Color fundus photograph.
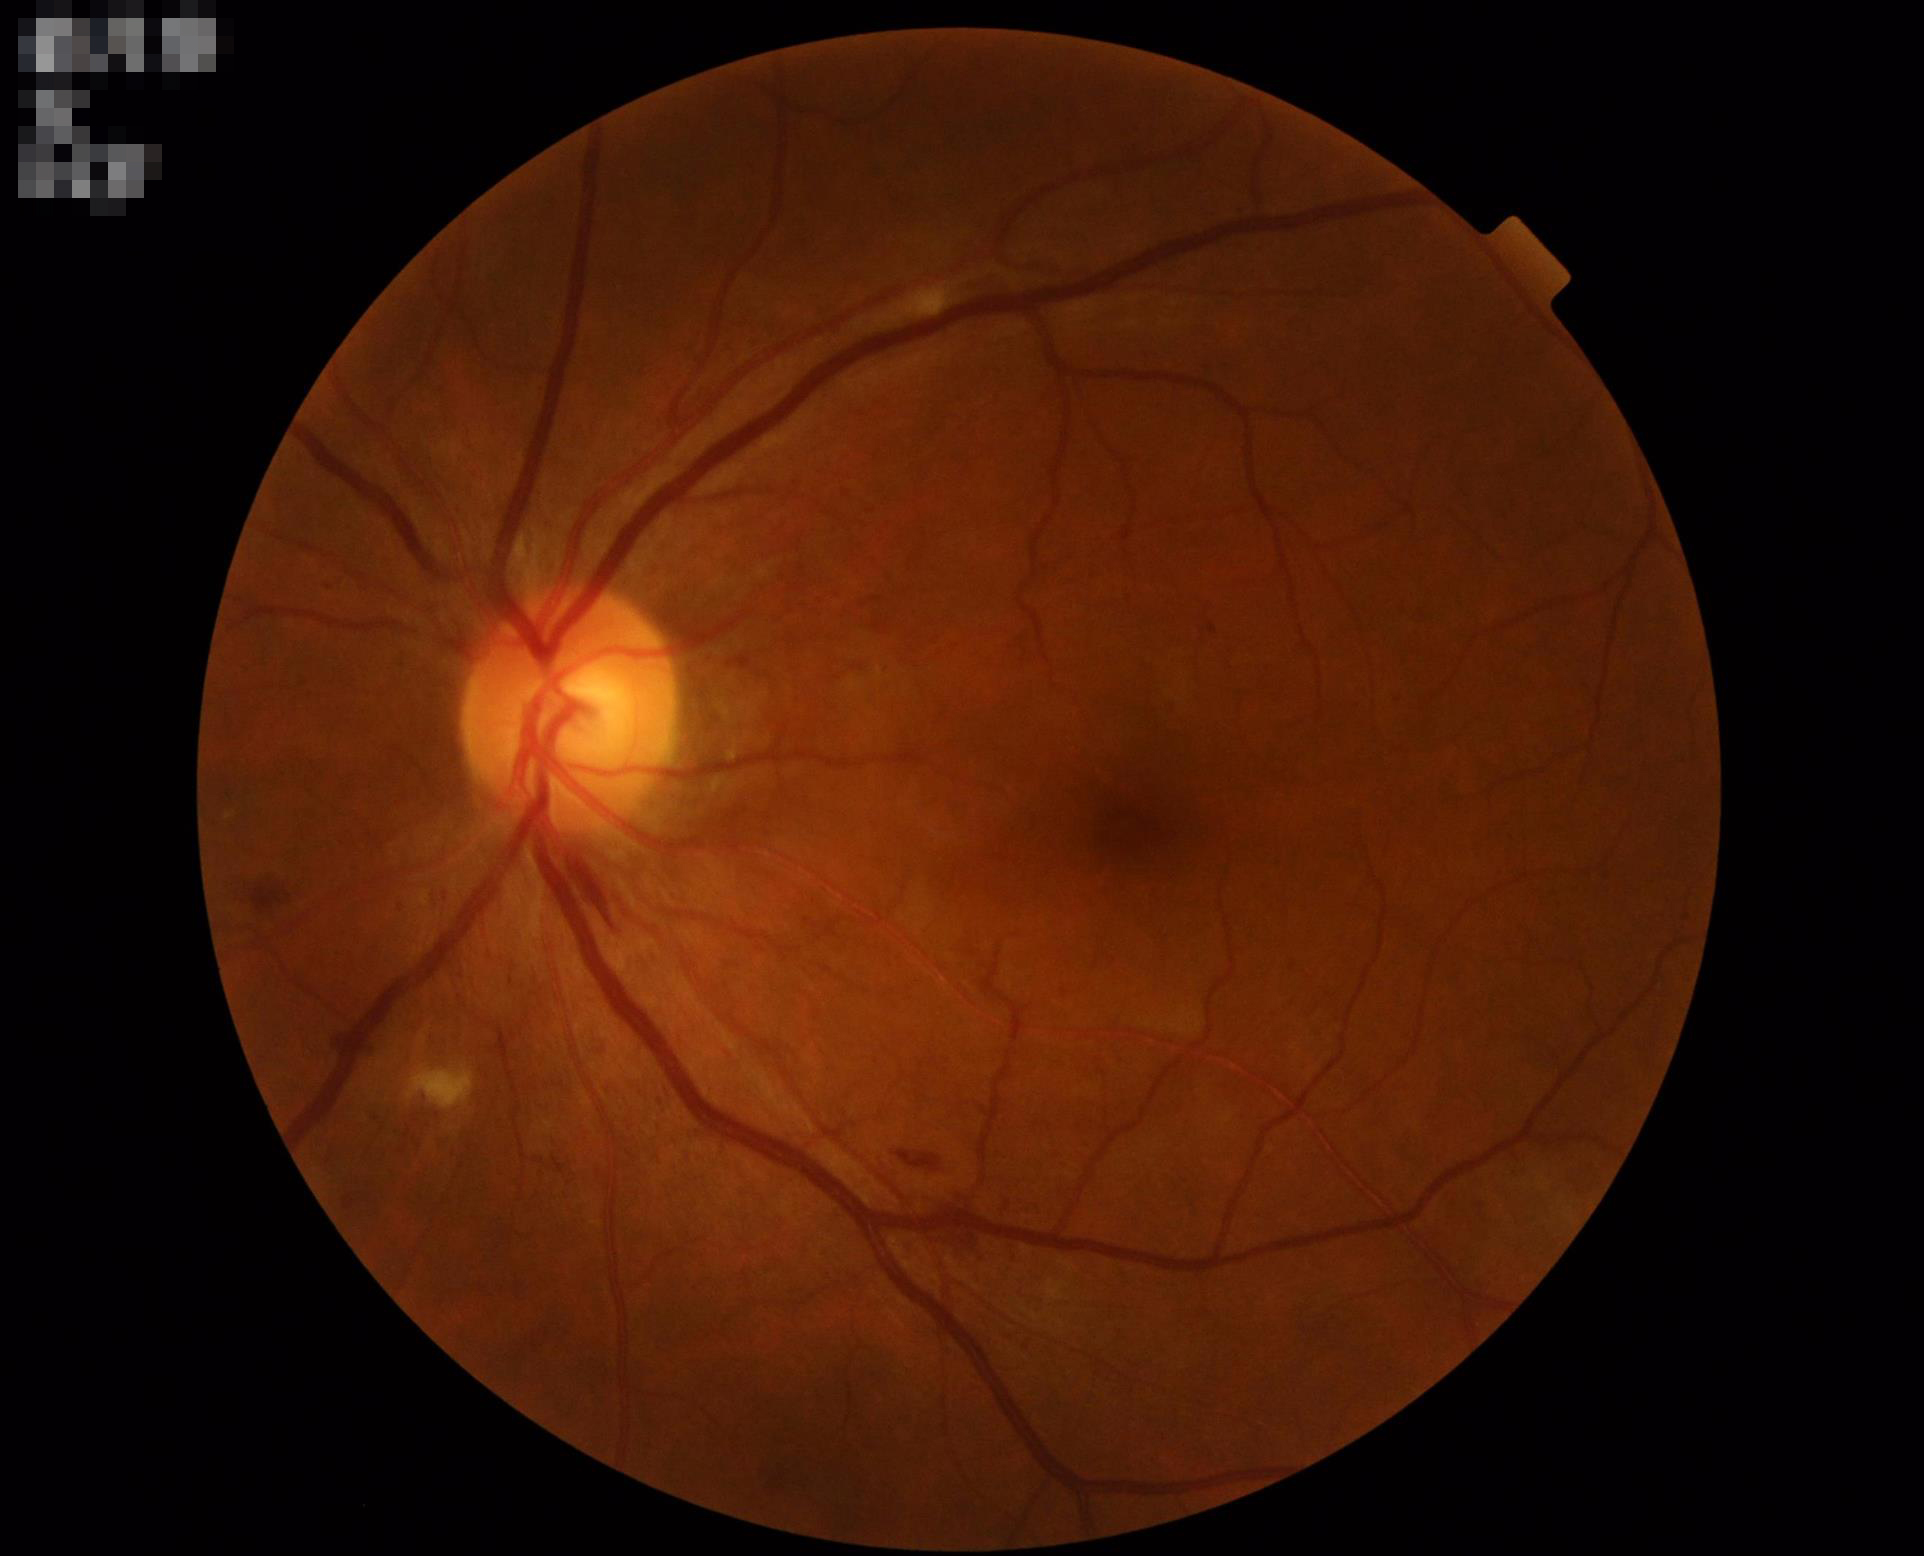
Quality assessment: contrast: good dynamic range | sharpness: clear with no noticeable blur | illumination/color: uniform, no color cast.